Davis DR grading:
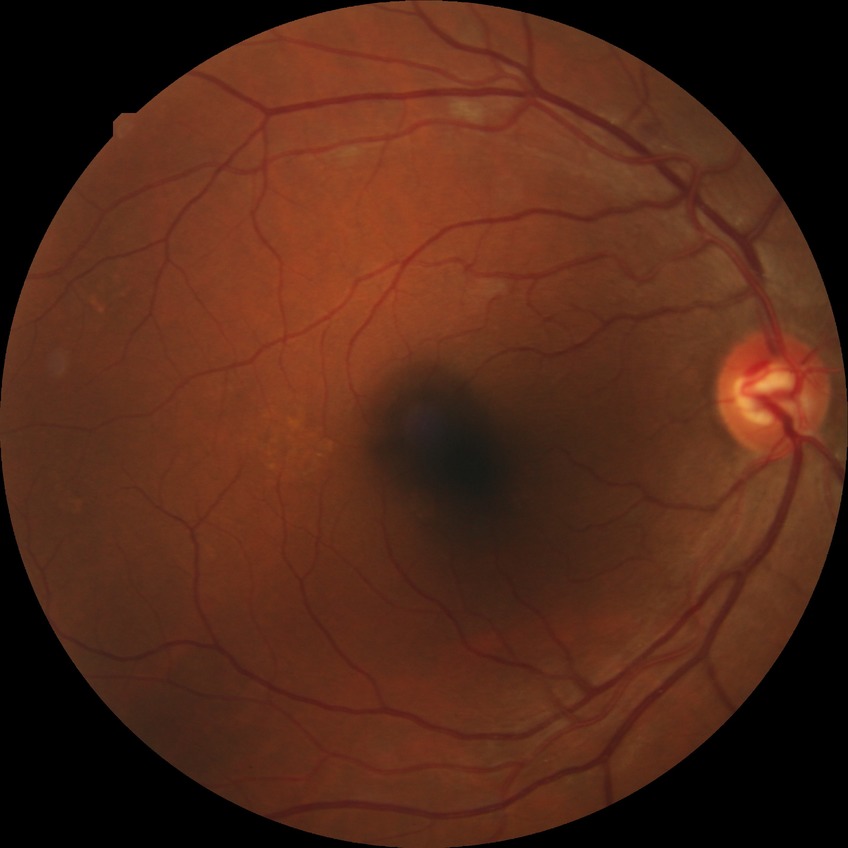 {"davis_grade": "NDR (no diabetic retinopathy)"}